Graded on the modified Davis scale; 45-degree field of view — 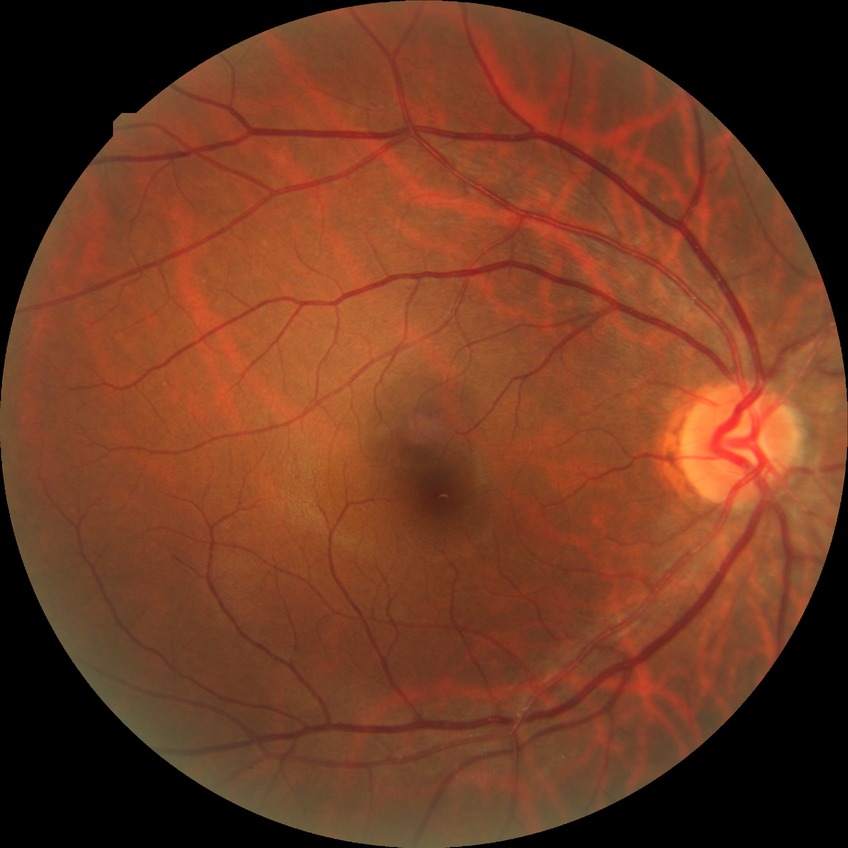
Retinopathy stage: no diabetic retinopathy.